2048 x 1536 pixels; color fundus photograph — 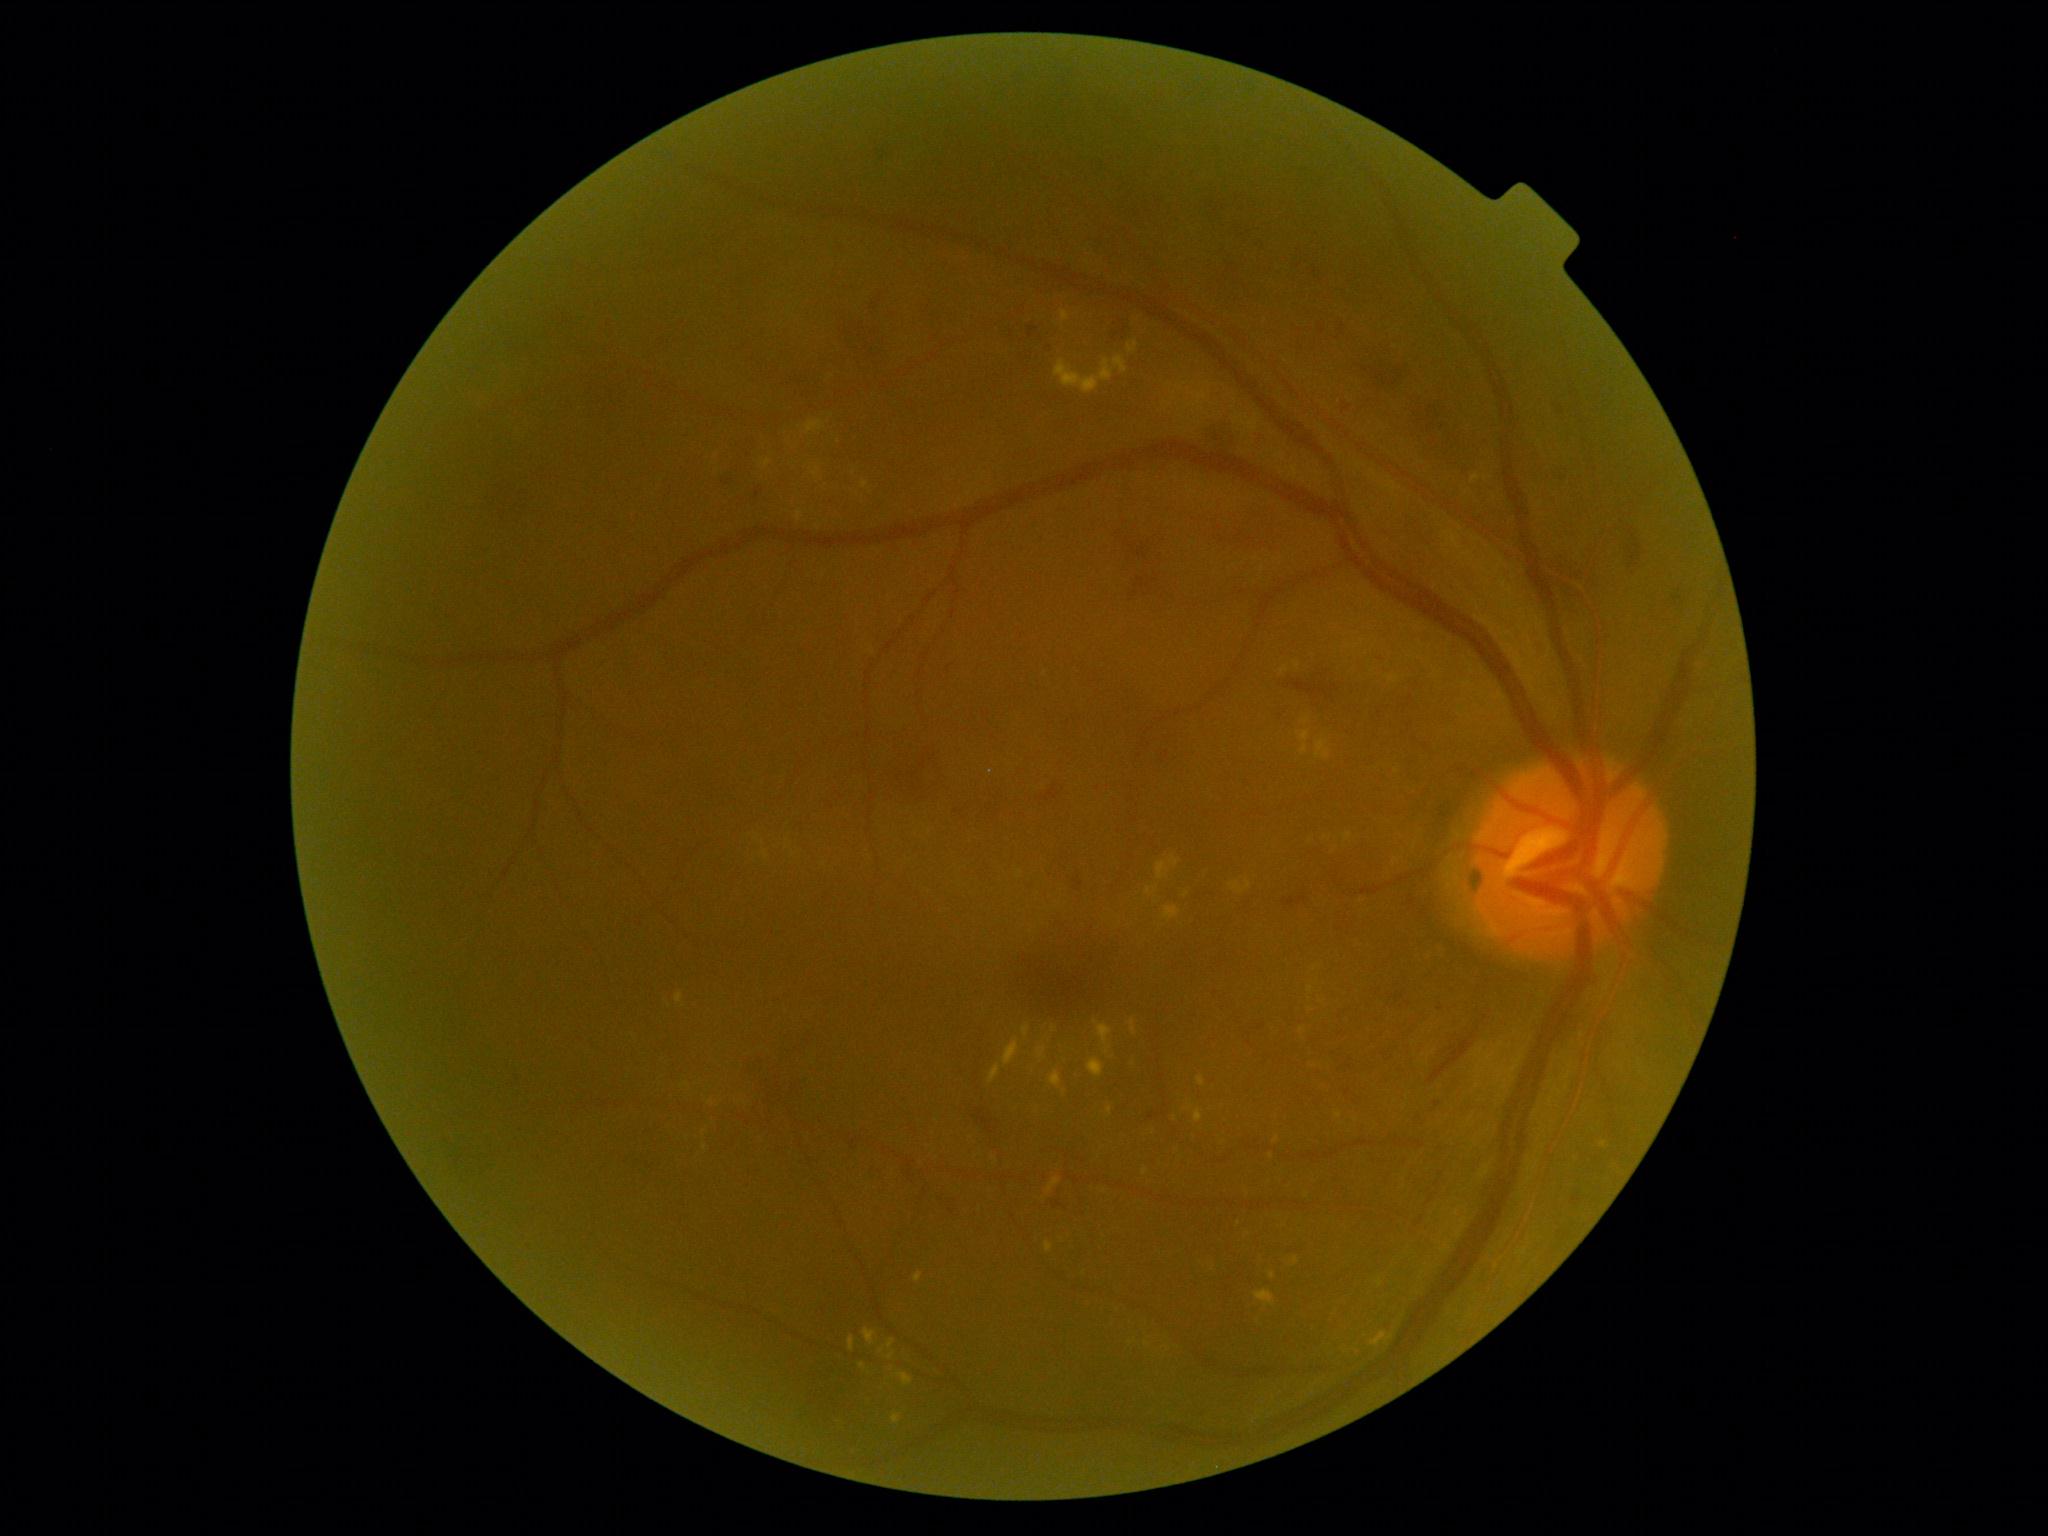 partial: true
dr_grade: 2
dr_grade_name: moderate NPDR
lesions:
  ex:
    - x1=1156, y1=862, x2=1171, y2=881
    - x1=1297, y1=731, x2=1311, y2=755
    - x1=897, y1=1374, x2=913, y2=1387
    - x1=1003, y1=1038, x2=1020, y2=1066
    - x1=1386, y1=676, x2=1400, y2=683
    - x1=764, y1=460, x2=771, y2=468
    - x1=914, y1=1272, x2=923, y2=1283
    - x1=1195, y1=1110, x2=1204, y2=1123
    - x1=880, y1=1339, x2=896, y2=1354
    - x1=762, y1=851, x2=768, y2=859
    - x1=1198, y1=1076, x2=1205, y2=1087
    - x1=676, y1=994, x2=684, y2=1004
  ex_small_approx:
    - <point>1272, 1275</point>
    - <point>1362, 902</point>
    - <point>1145, 1172</point>
    - <point>1147, 1344</point>
    - <point>1239, 1224</point>
    - <point>711, 1103</point>
    - <point>704, 1132</point>